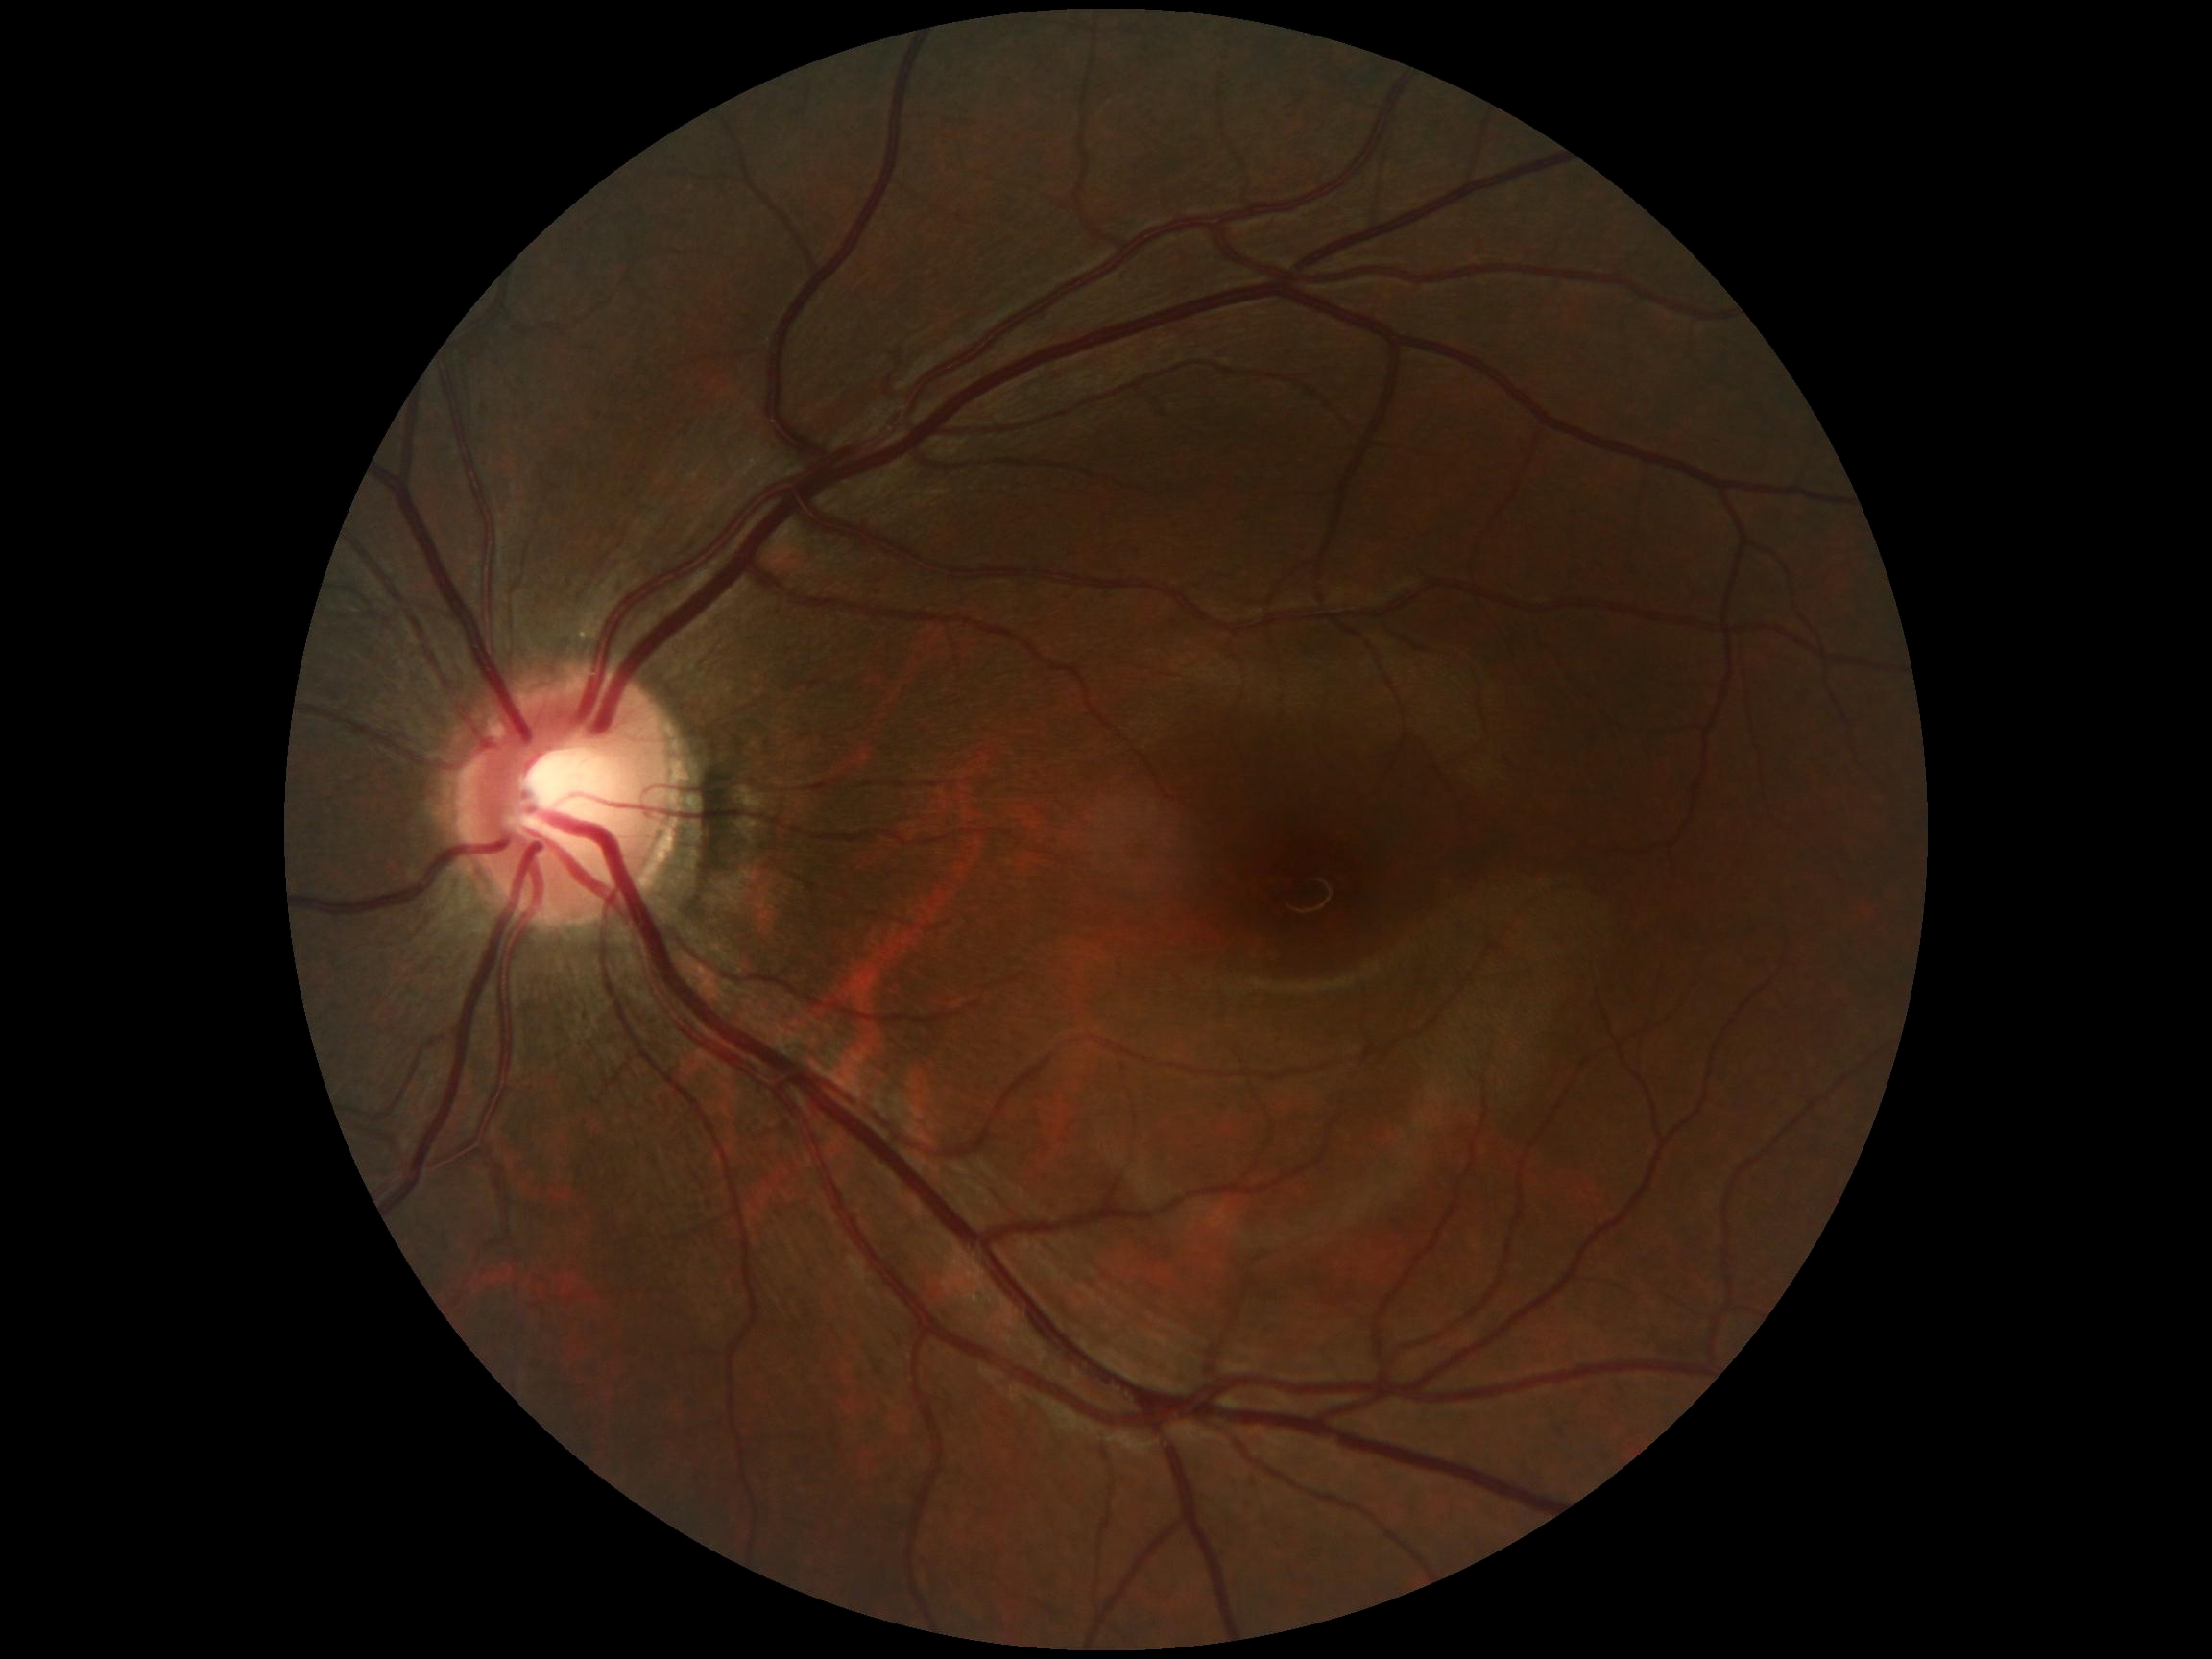 {
  "dr_grade": "grade 0 (no apparent retinopathy)",
  "dr_impression": "no signs of DR"
}